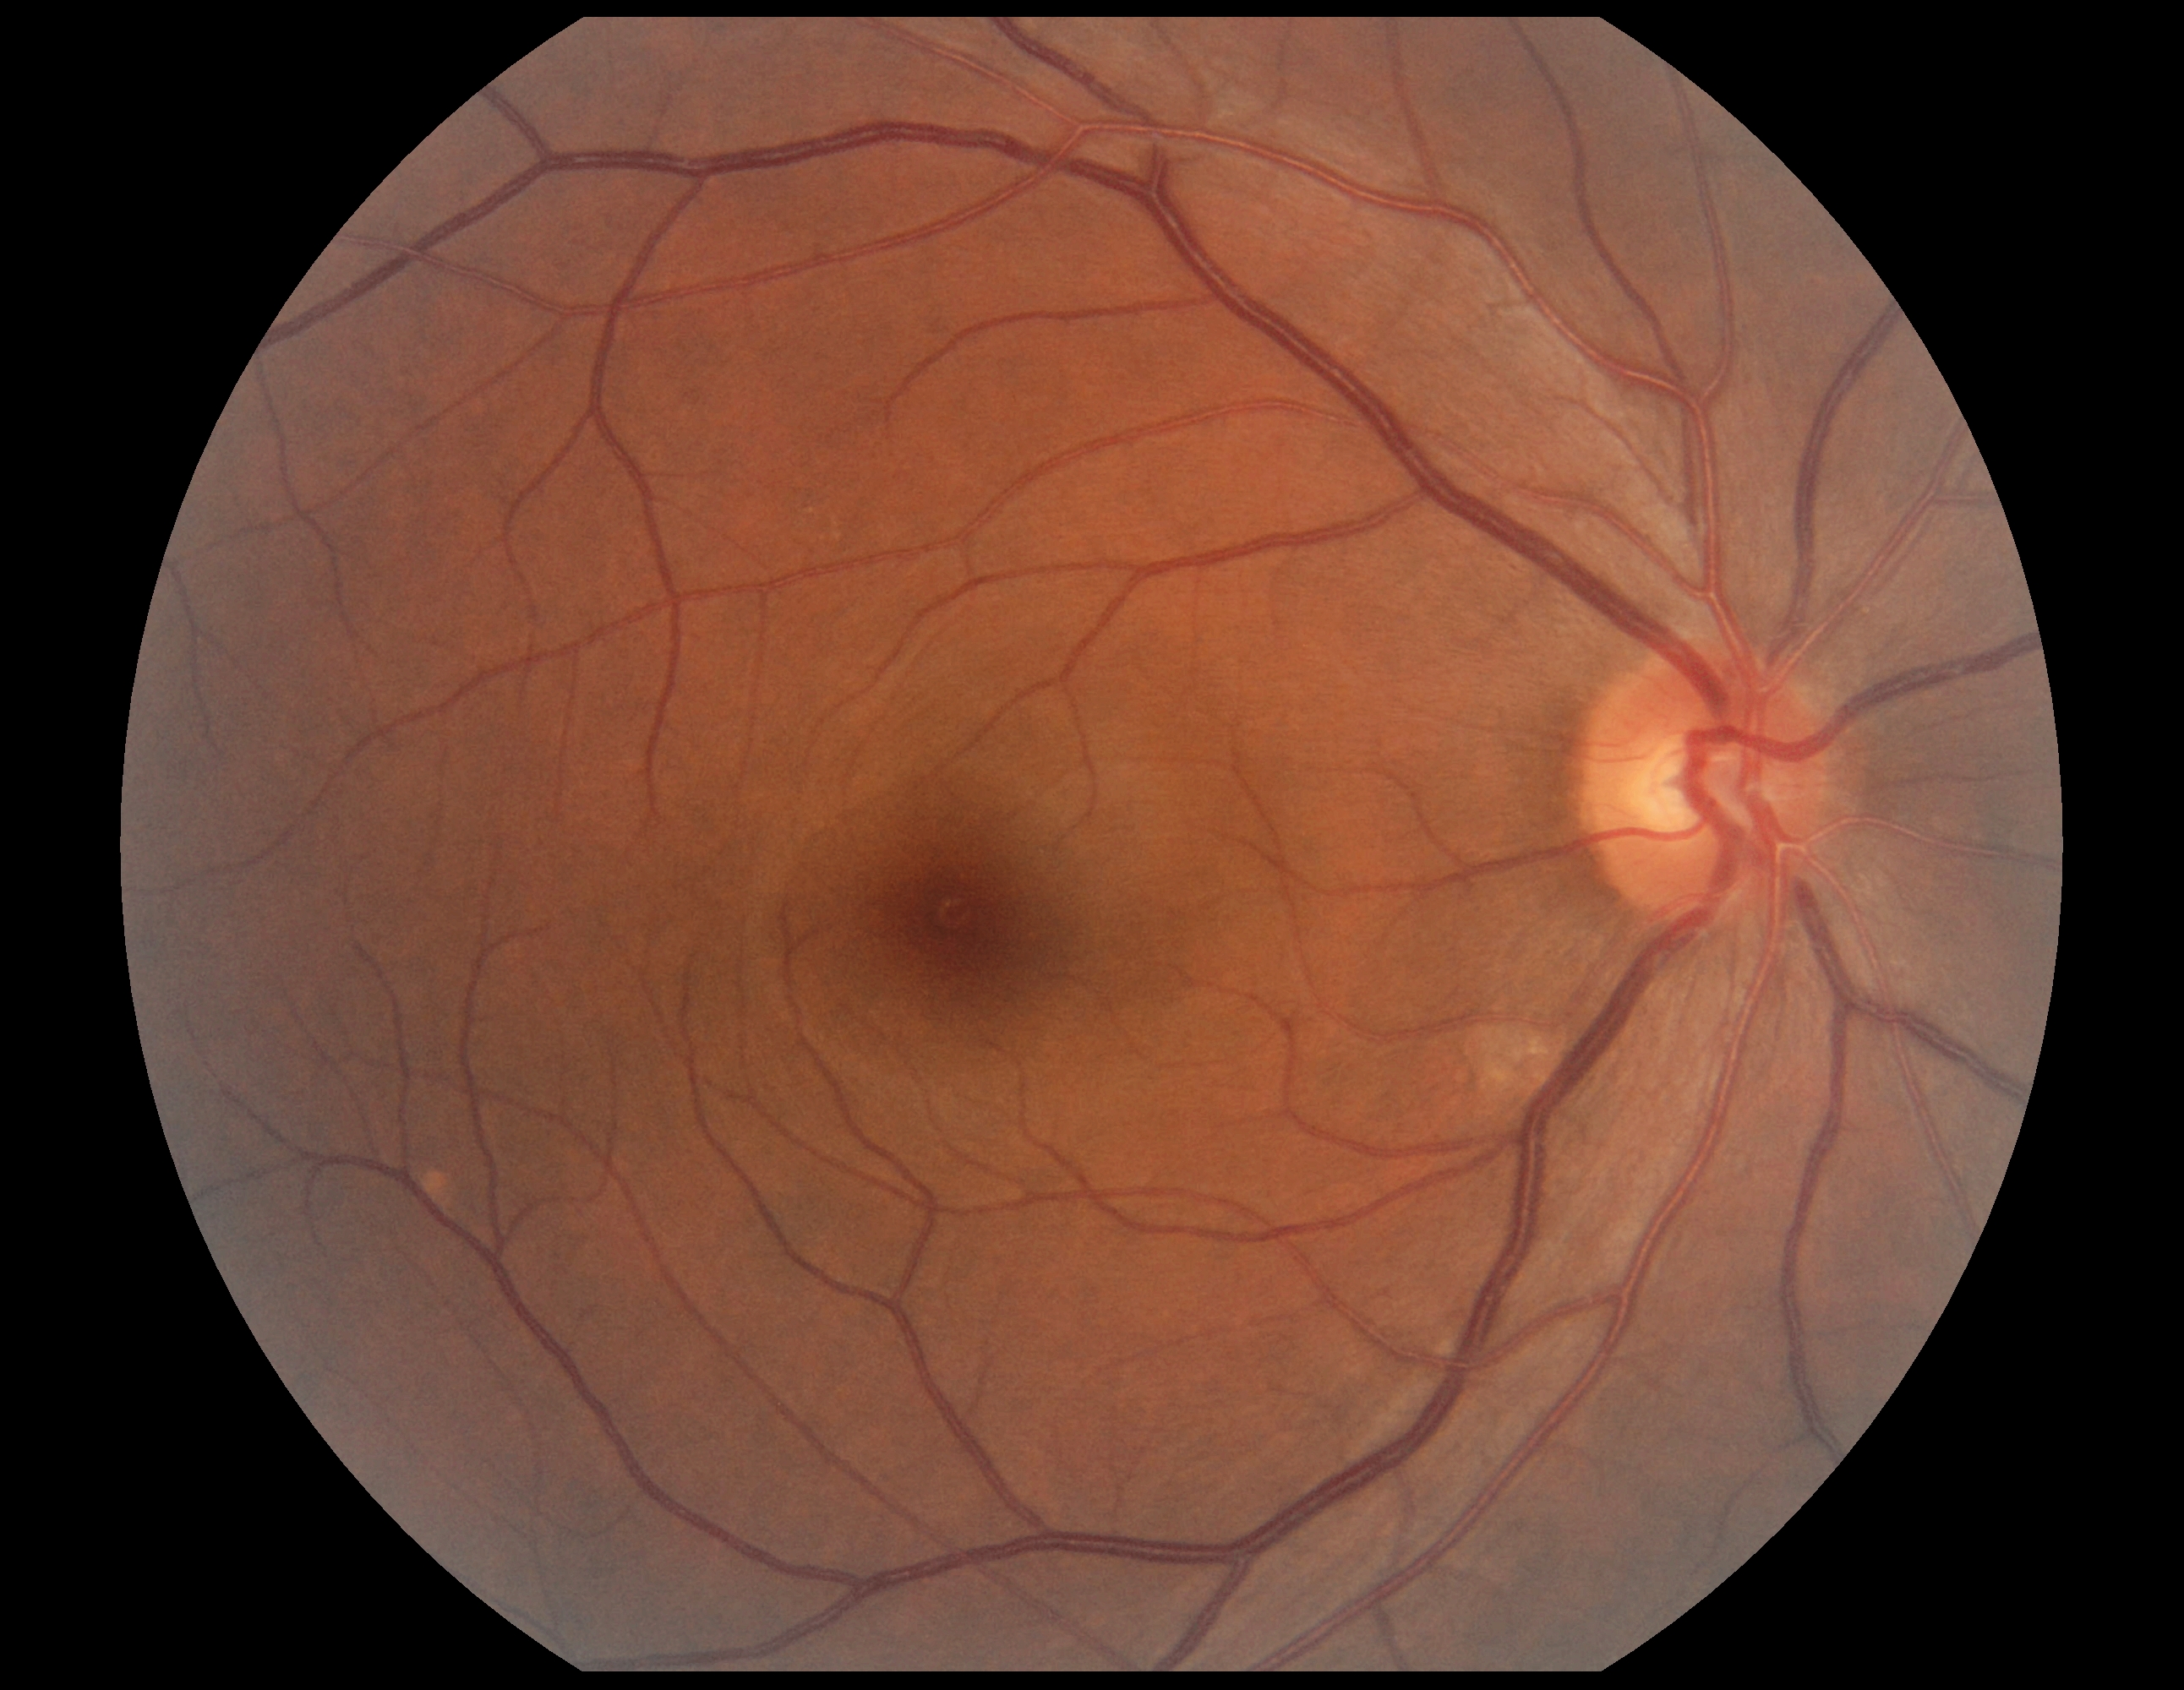
DR impression = no apparent DR
DR stage = 0